Pediatric retinal photograph (wide-field). Camera: Phoenix ICON (100° FOV): 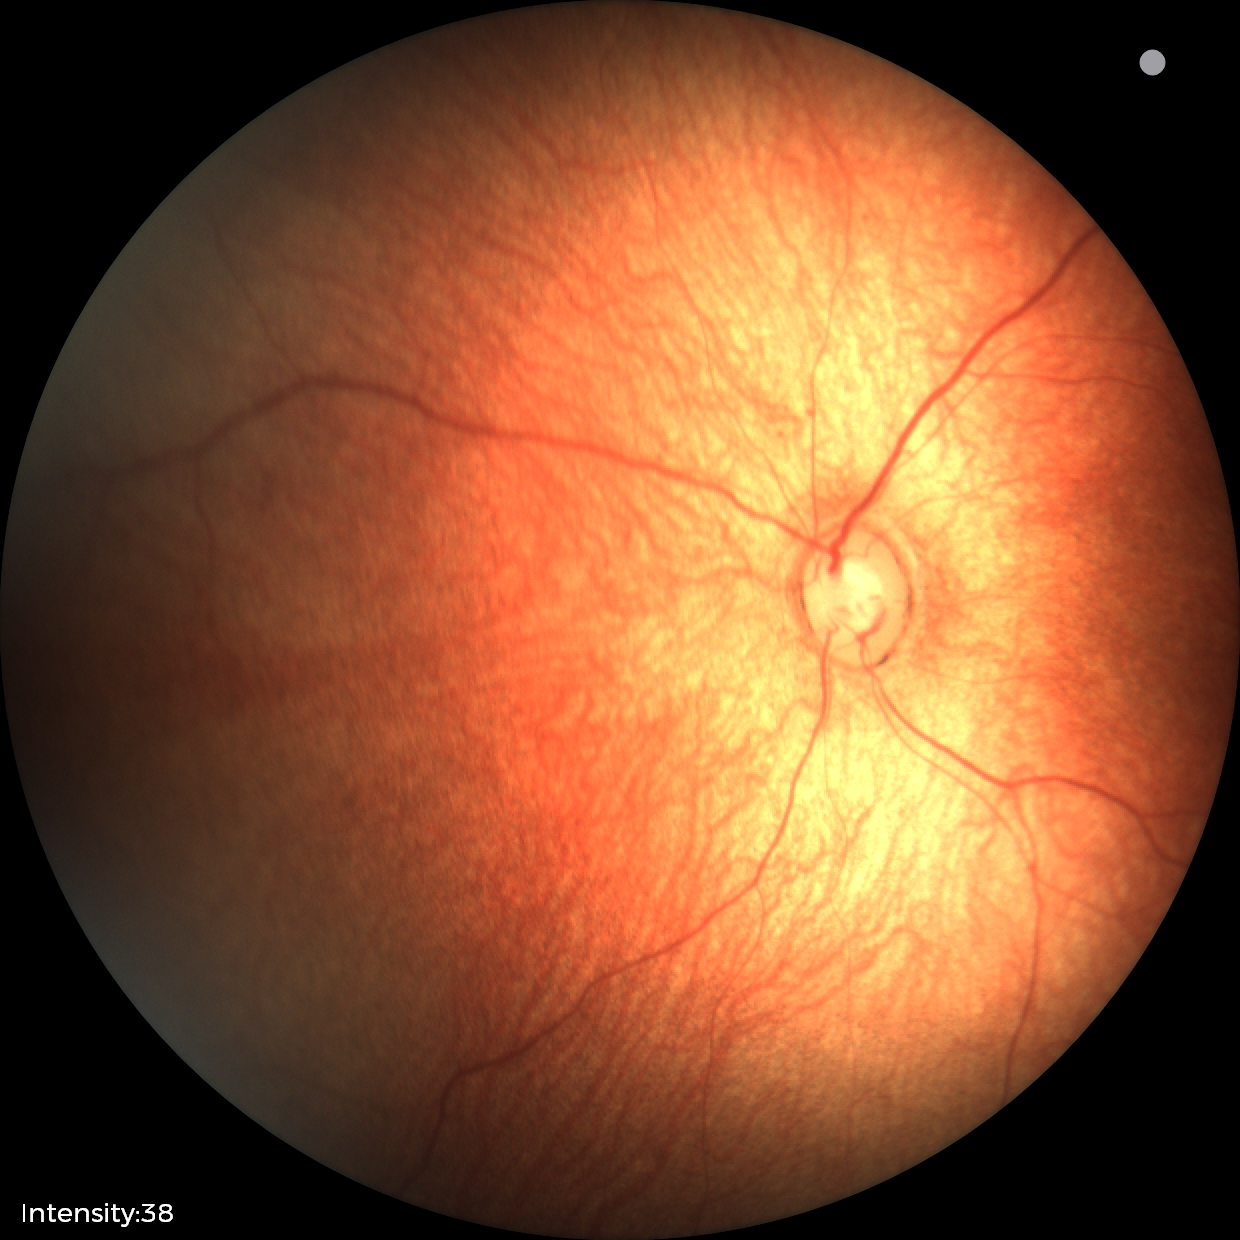 Screening examination diagnosed as physiological.